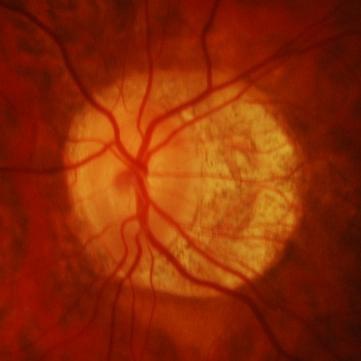
Diagnosis = glaucoma.